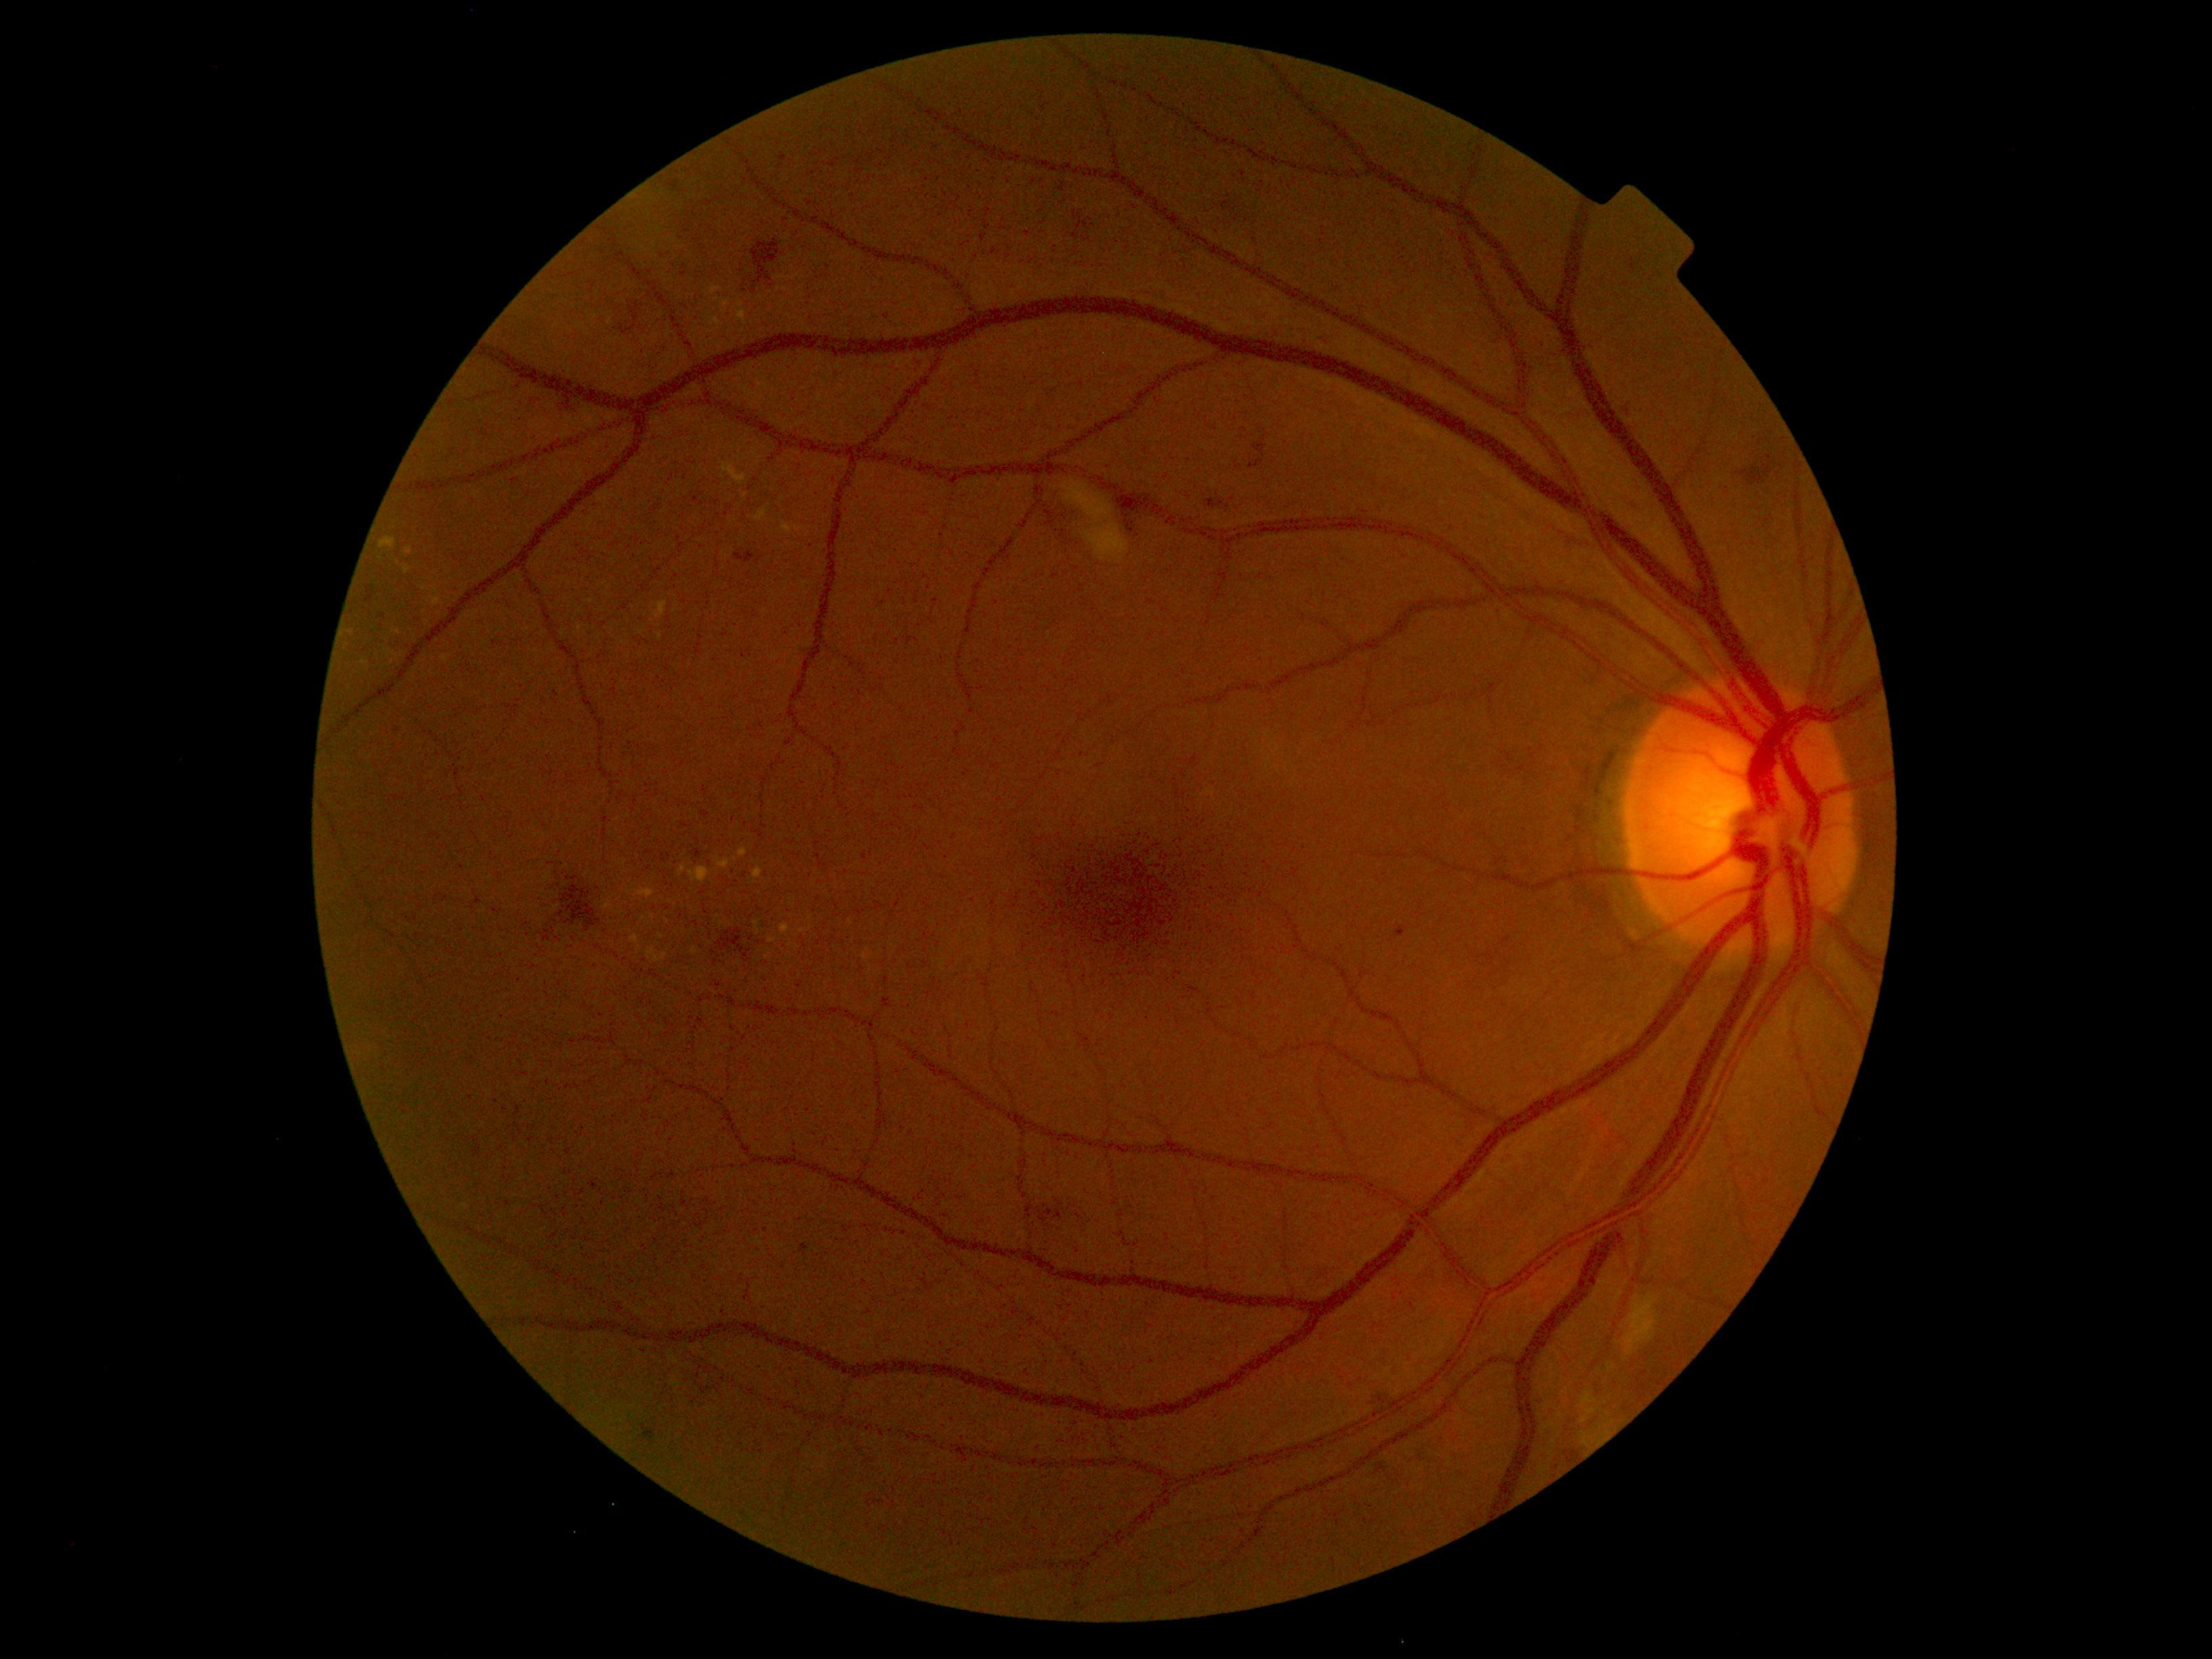

DR severity is moderate non-proliferative diabetic retinopathy (grade 2)
A subset of detected lesions:
SEs (partial) = region(1580, 1393, 1599, 1416) | region(1584, 1433, 1593, 1447) | region(1582, 1417, 1589, 1425) | region(1061, 479, 1130, 565) | region(1622, 1292, 1661, 1356)
HEs (partial) = region(716, 929, 752, 962) | region(558, 394, 574, 415) | region(1249, 437, 1267, 468) | region(1372, 1383, 1390, 1410) | region(1071, 232, 1078, 241) | region(562, 886, 600, 932) | region(1113, 499, 1136, 535) | region(1032, 1199, 1073, 1216) | region(1073, 211, 1090, 231) | region(621, 304, 639, 335) | region(567, 876, 579, 880) | region(1375, 1463, 1389, 1474) | region(1738, 460, 1772, 486) | region(752, 239, 780, 284)
EXs (partial) = region(386, 650, 395, 658) | region(734, 300, 746, 325) | region(432, 597, 441, 607) | region(753, 867, 764, 879) | region(406, 546, 413, 555) | region(678, 865, 688, 878) | region(715, 857, 731, 869) | region(704, 316, 723, 335) | region(720, 460, 747, 486) | region(754, 508, 769, 523) | region(403, 566, 411, 574) | region(379, 537, 396, 550) | region(630, 935, 639, 945)
Small EXs near (351; 633) | (695; 952) | (652; 621) | (694; 911) | (851; 922) | (811; 919) | (365; 663)
MAs = region(1395, 925, 1408, 939) | region(643, 1424, 655, 1444) | region(735, 552, 756, 563) | region(693, 849, 701, 857) | region(590, 1180, 597, 1189) | region(800, 1244, 808, 1257) | region(1208, 499, 1223, 509) | region(742, 651, 746, 659) | region(668, 181, 680, 192) | region(365, 592, 373, 604) | region(780, 155, 788, 162)
Small MAs near (696; 500) | (385; 617) | (516; 481)